Image size 1240x1240; wide-field fundus photograph of an infant:
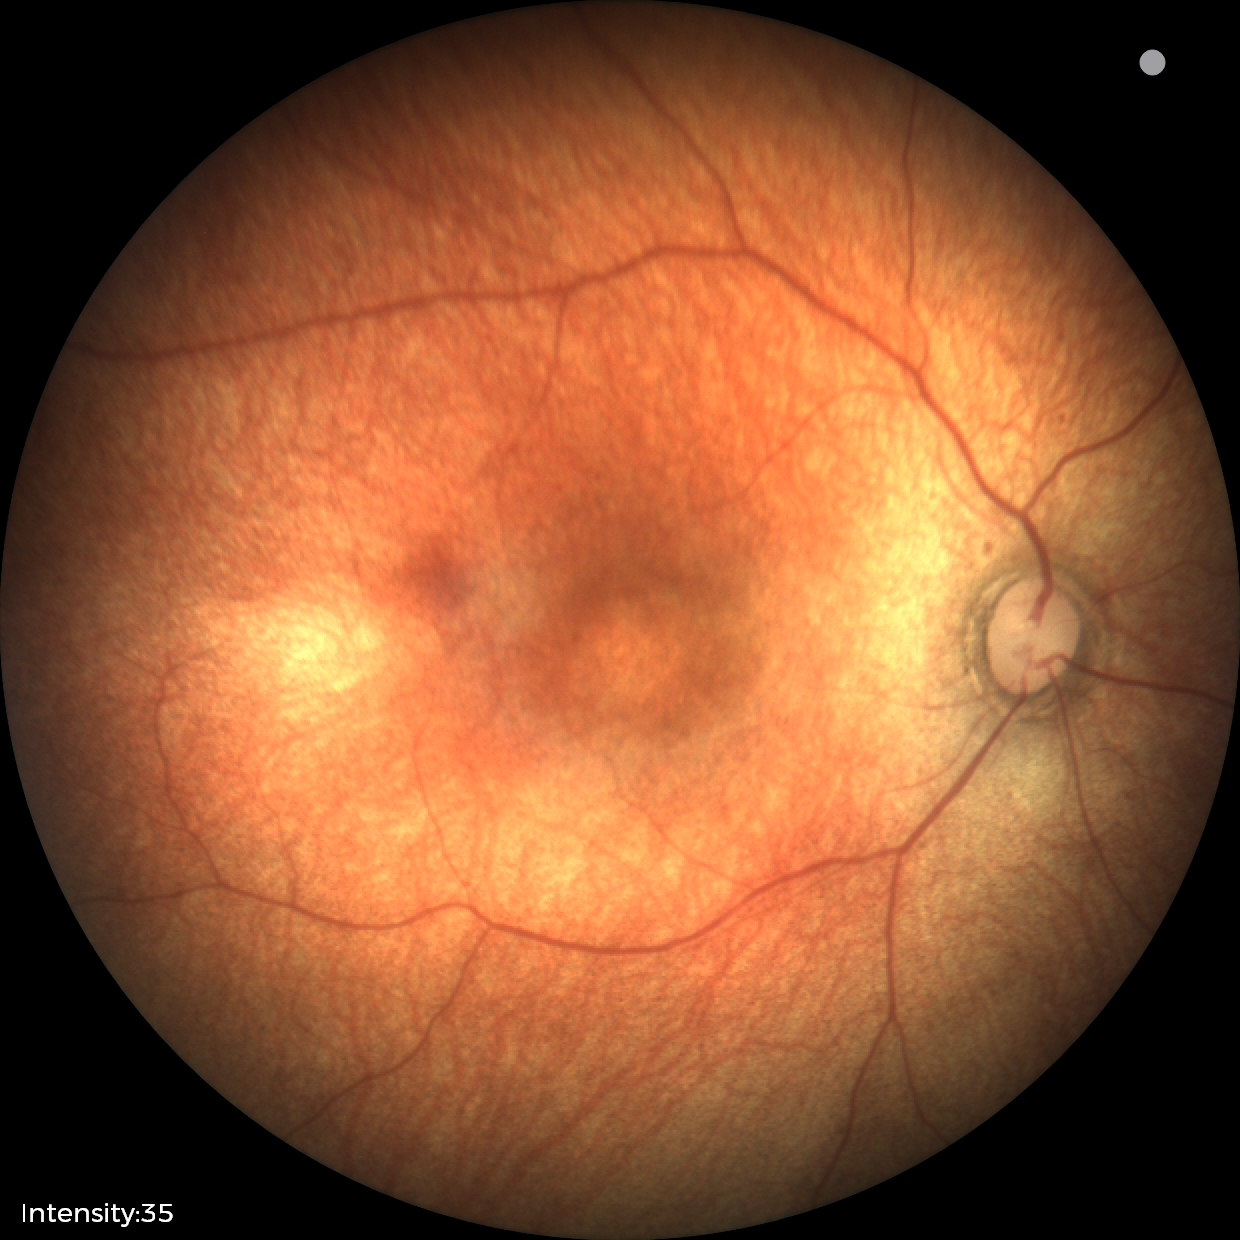
Diagnosis = physiological.